2352 by 1568 pixels.
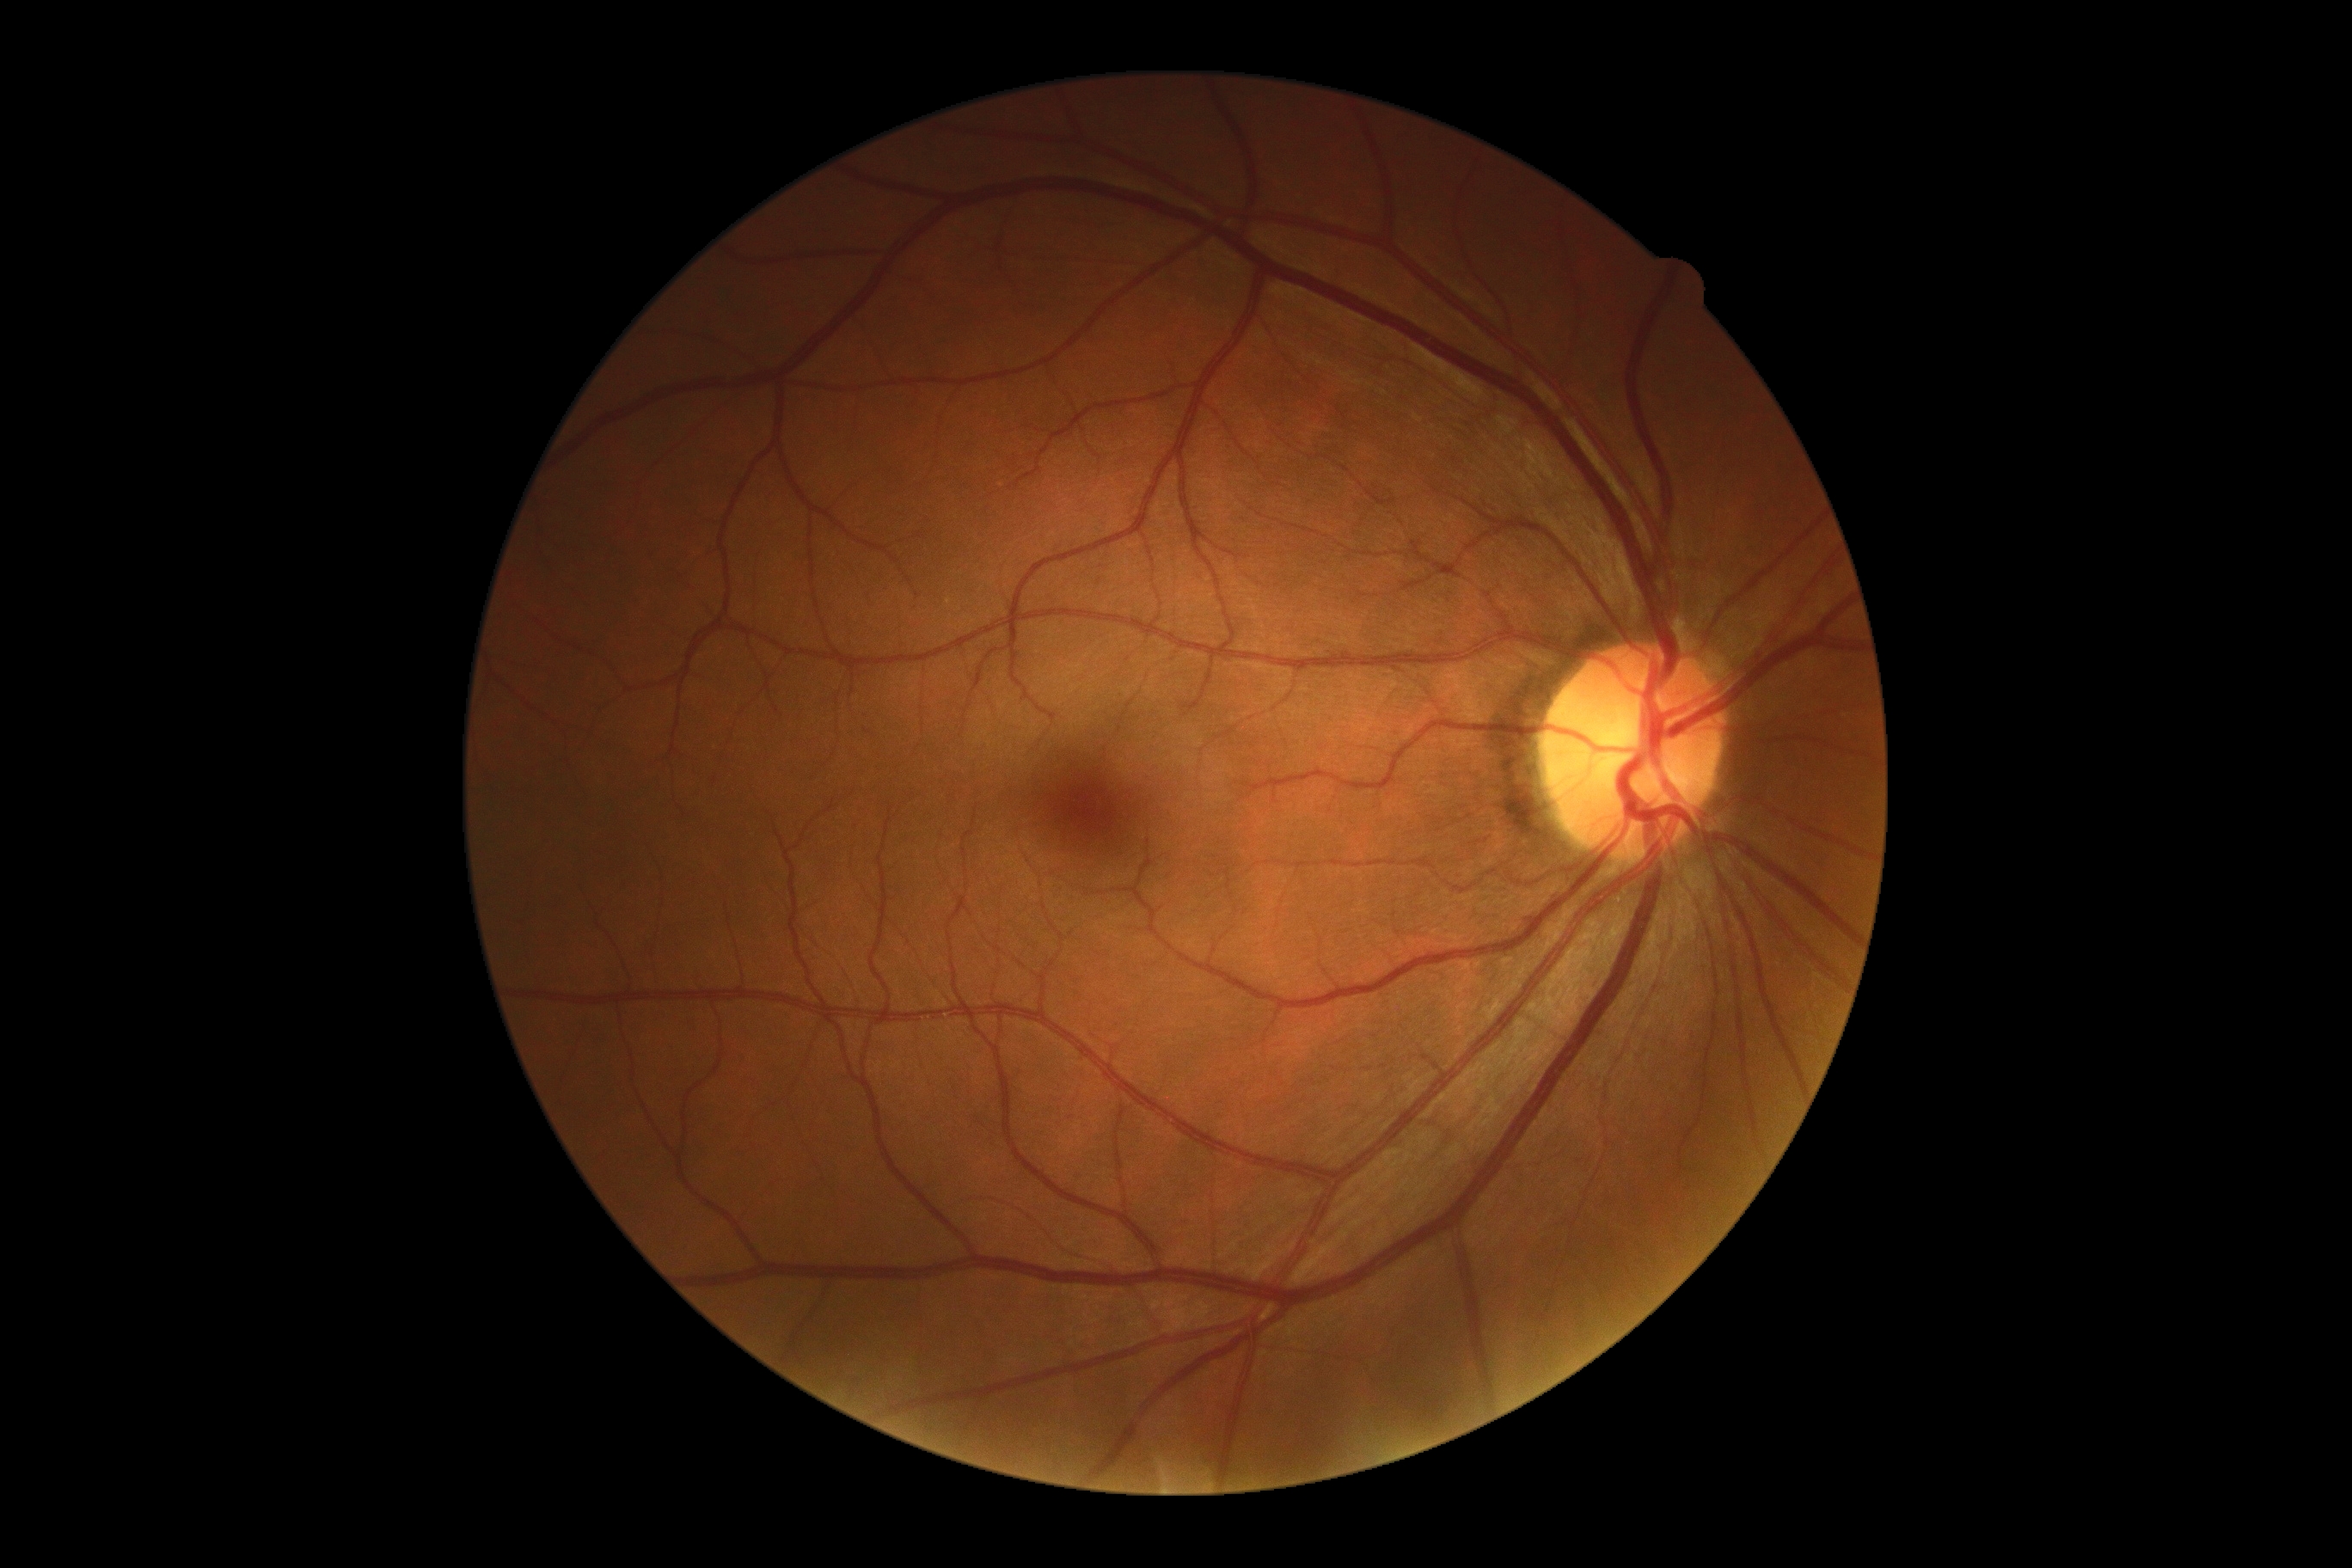 diabetic retinopathy (DR)@no apparent diabetic retinopathy (grade 0), DR impression@no signs of DR.